Wide-field contact fundus photograph of an infant — 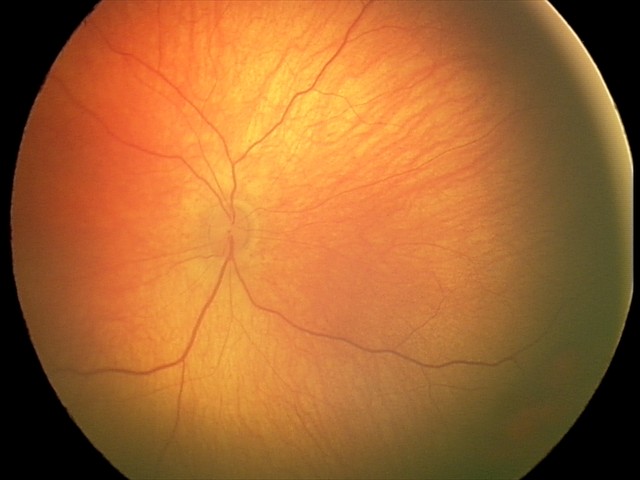 Examination diagnosed as retinal hemorrhages.